2352x1568. 45° field of view.
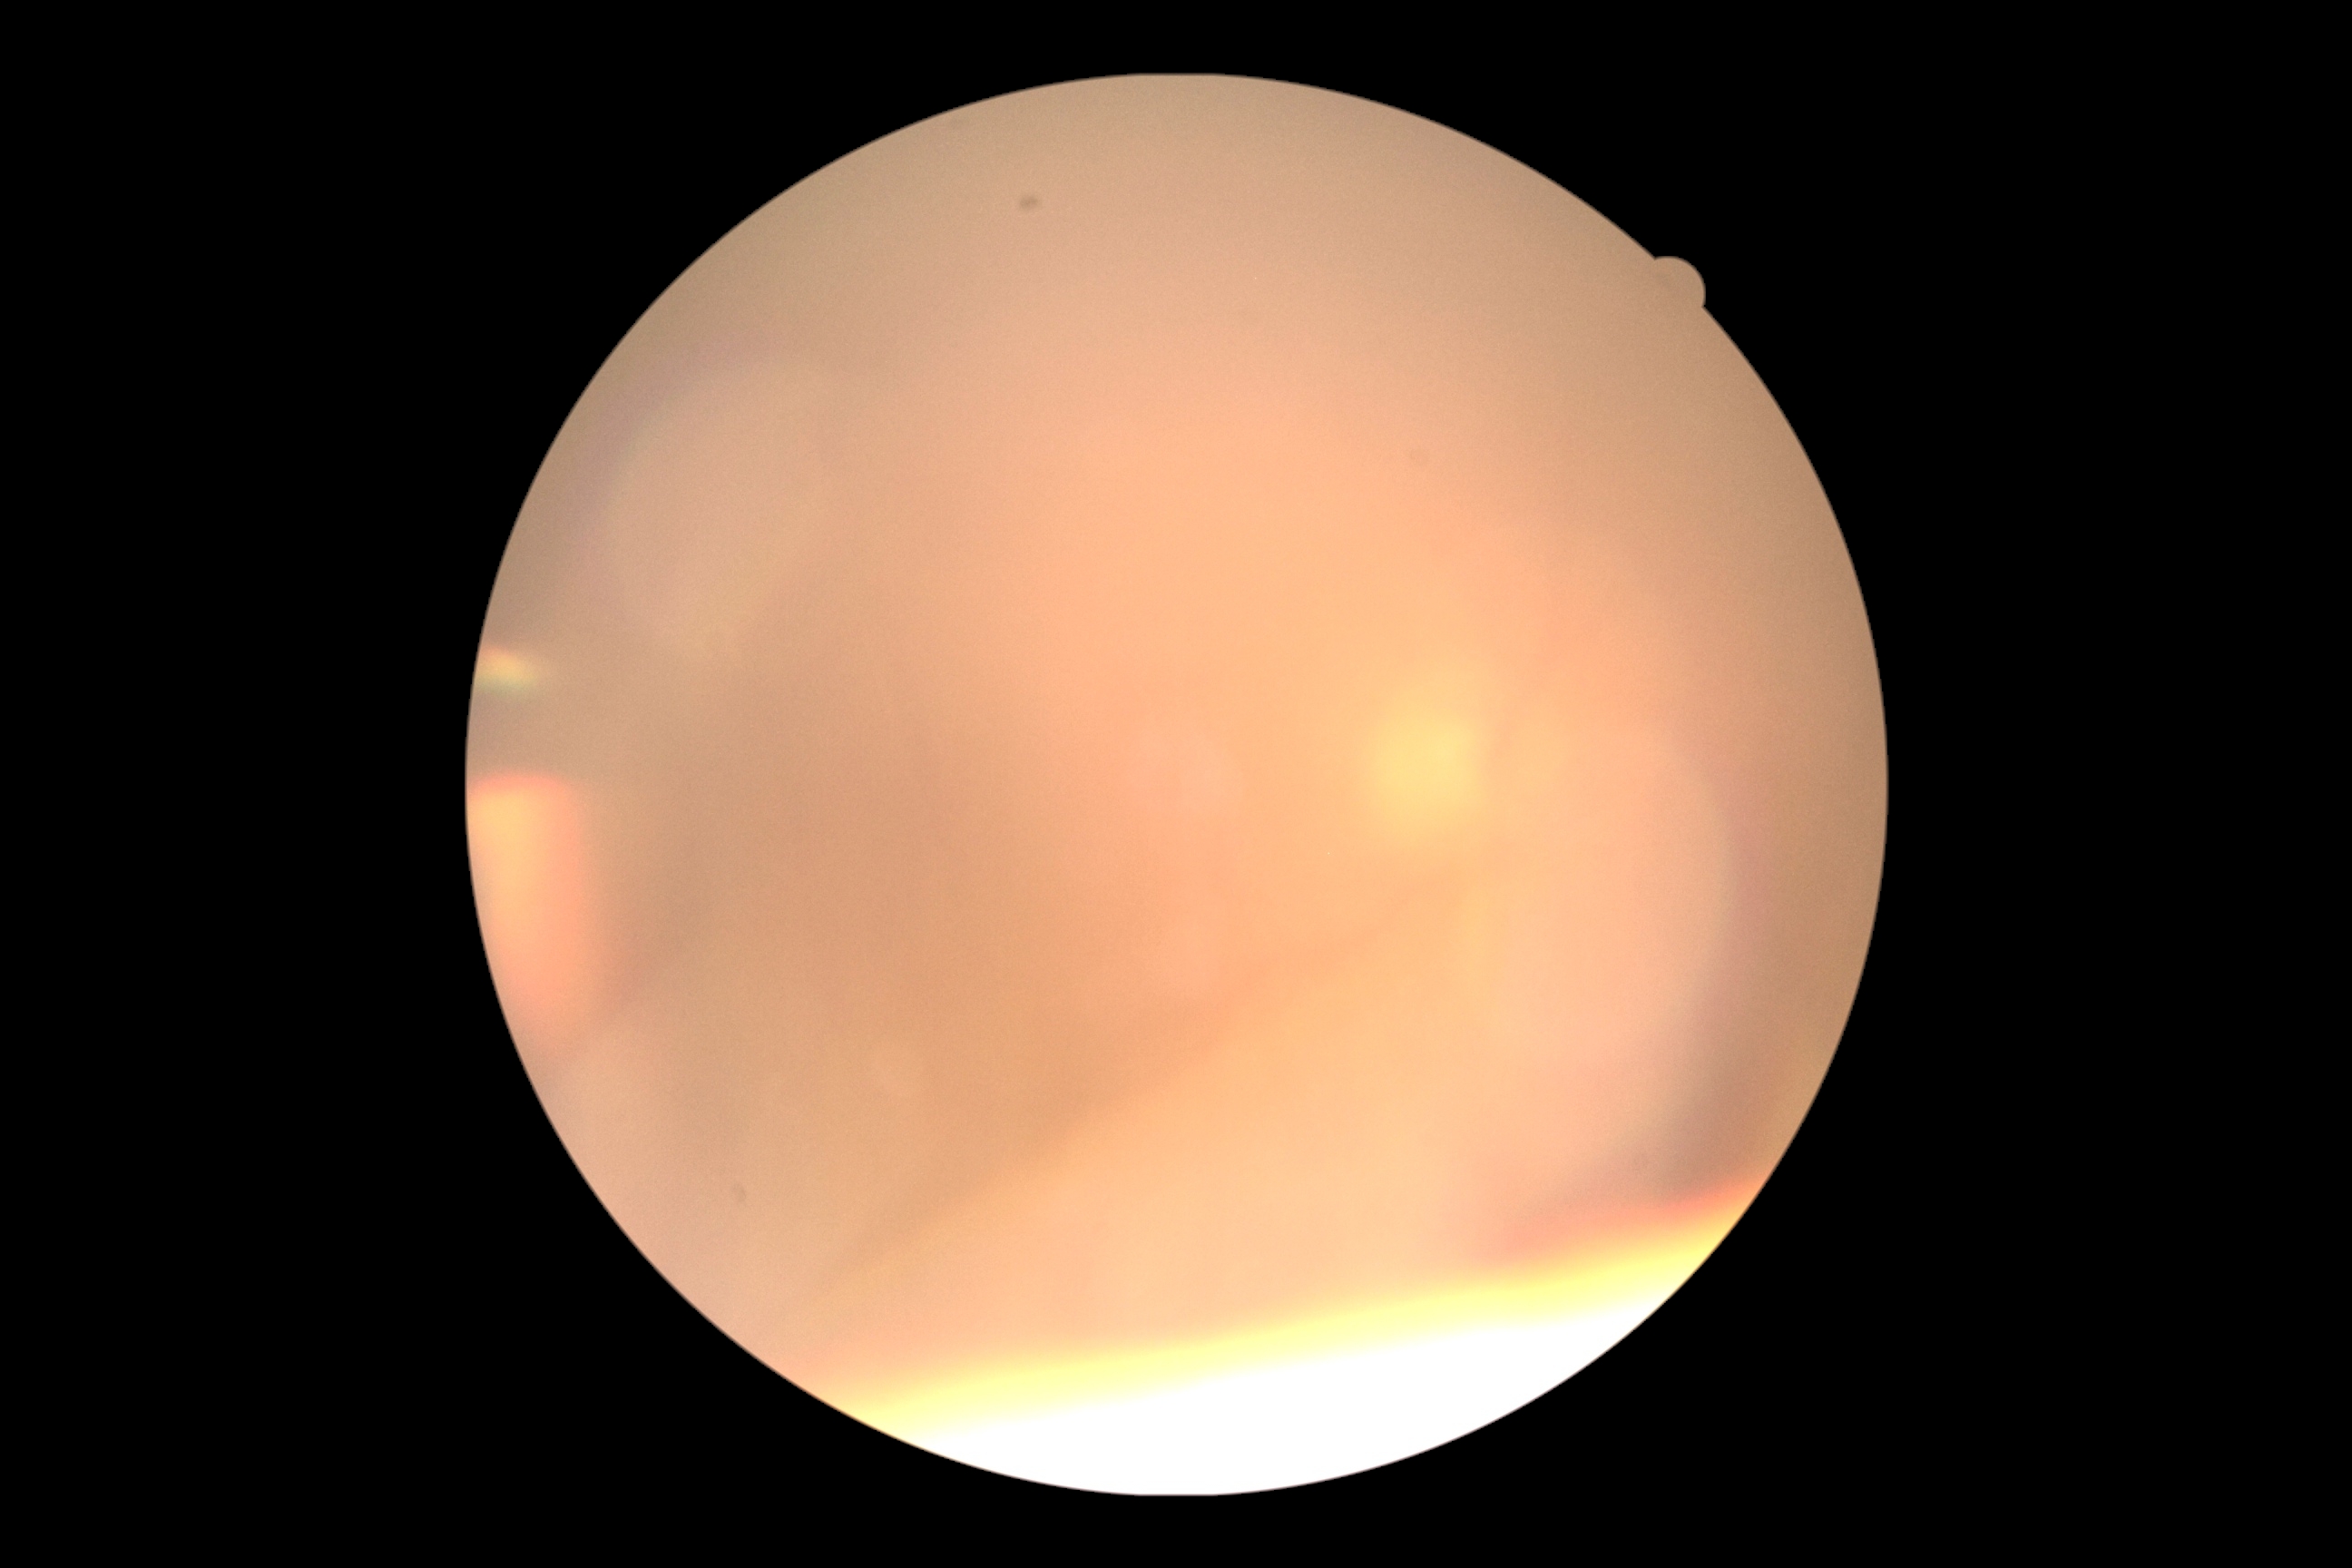

Quality too poor to assess for DR.
Diabetic retinopathy grade: ungradable due to poor image quality.